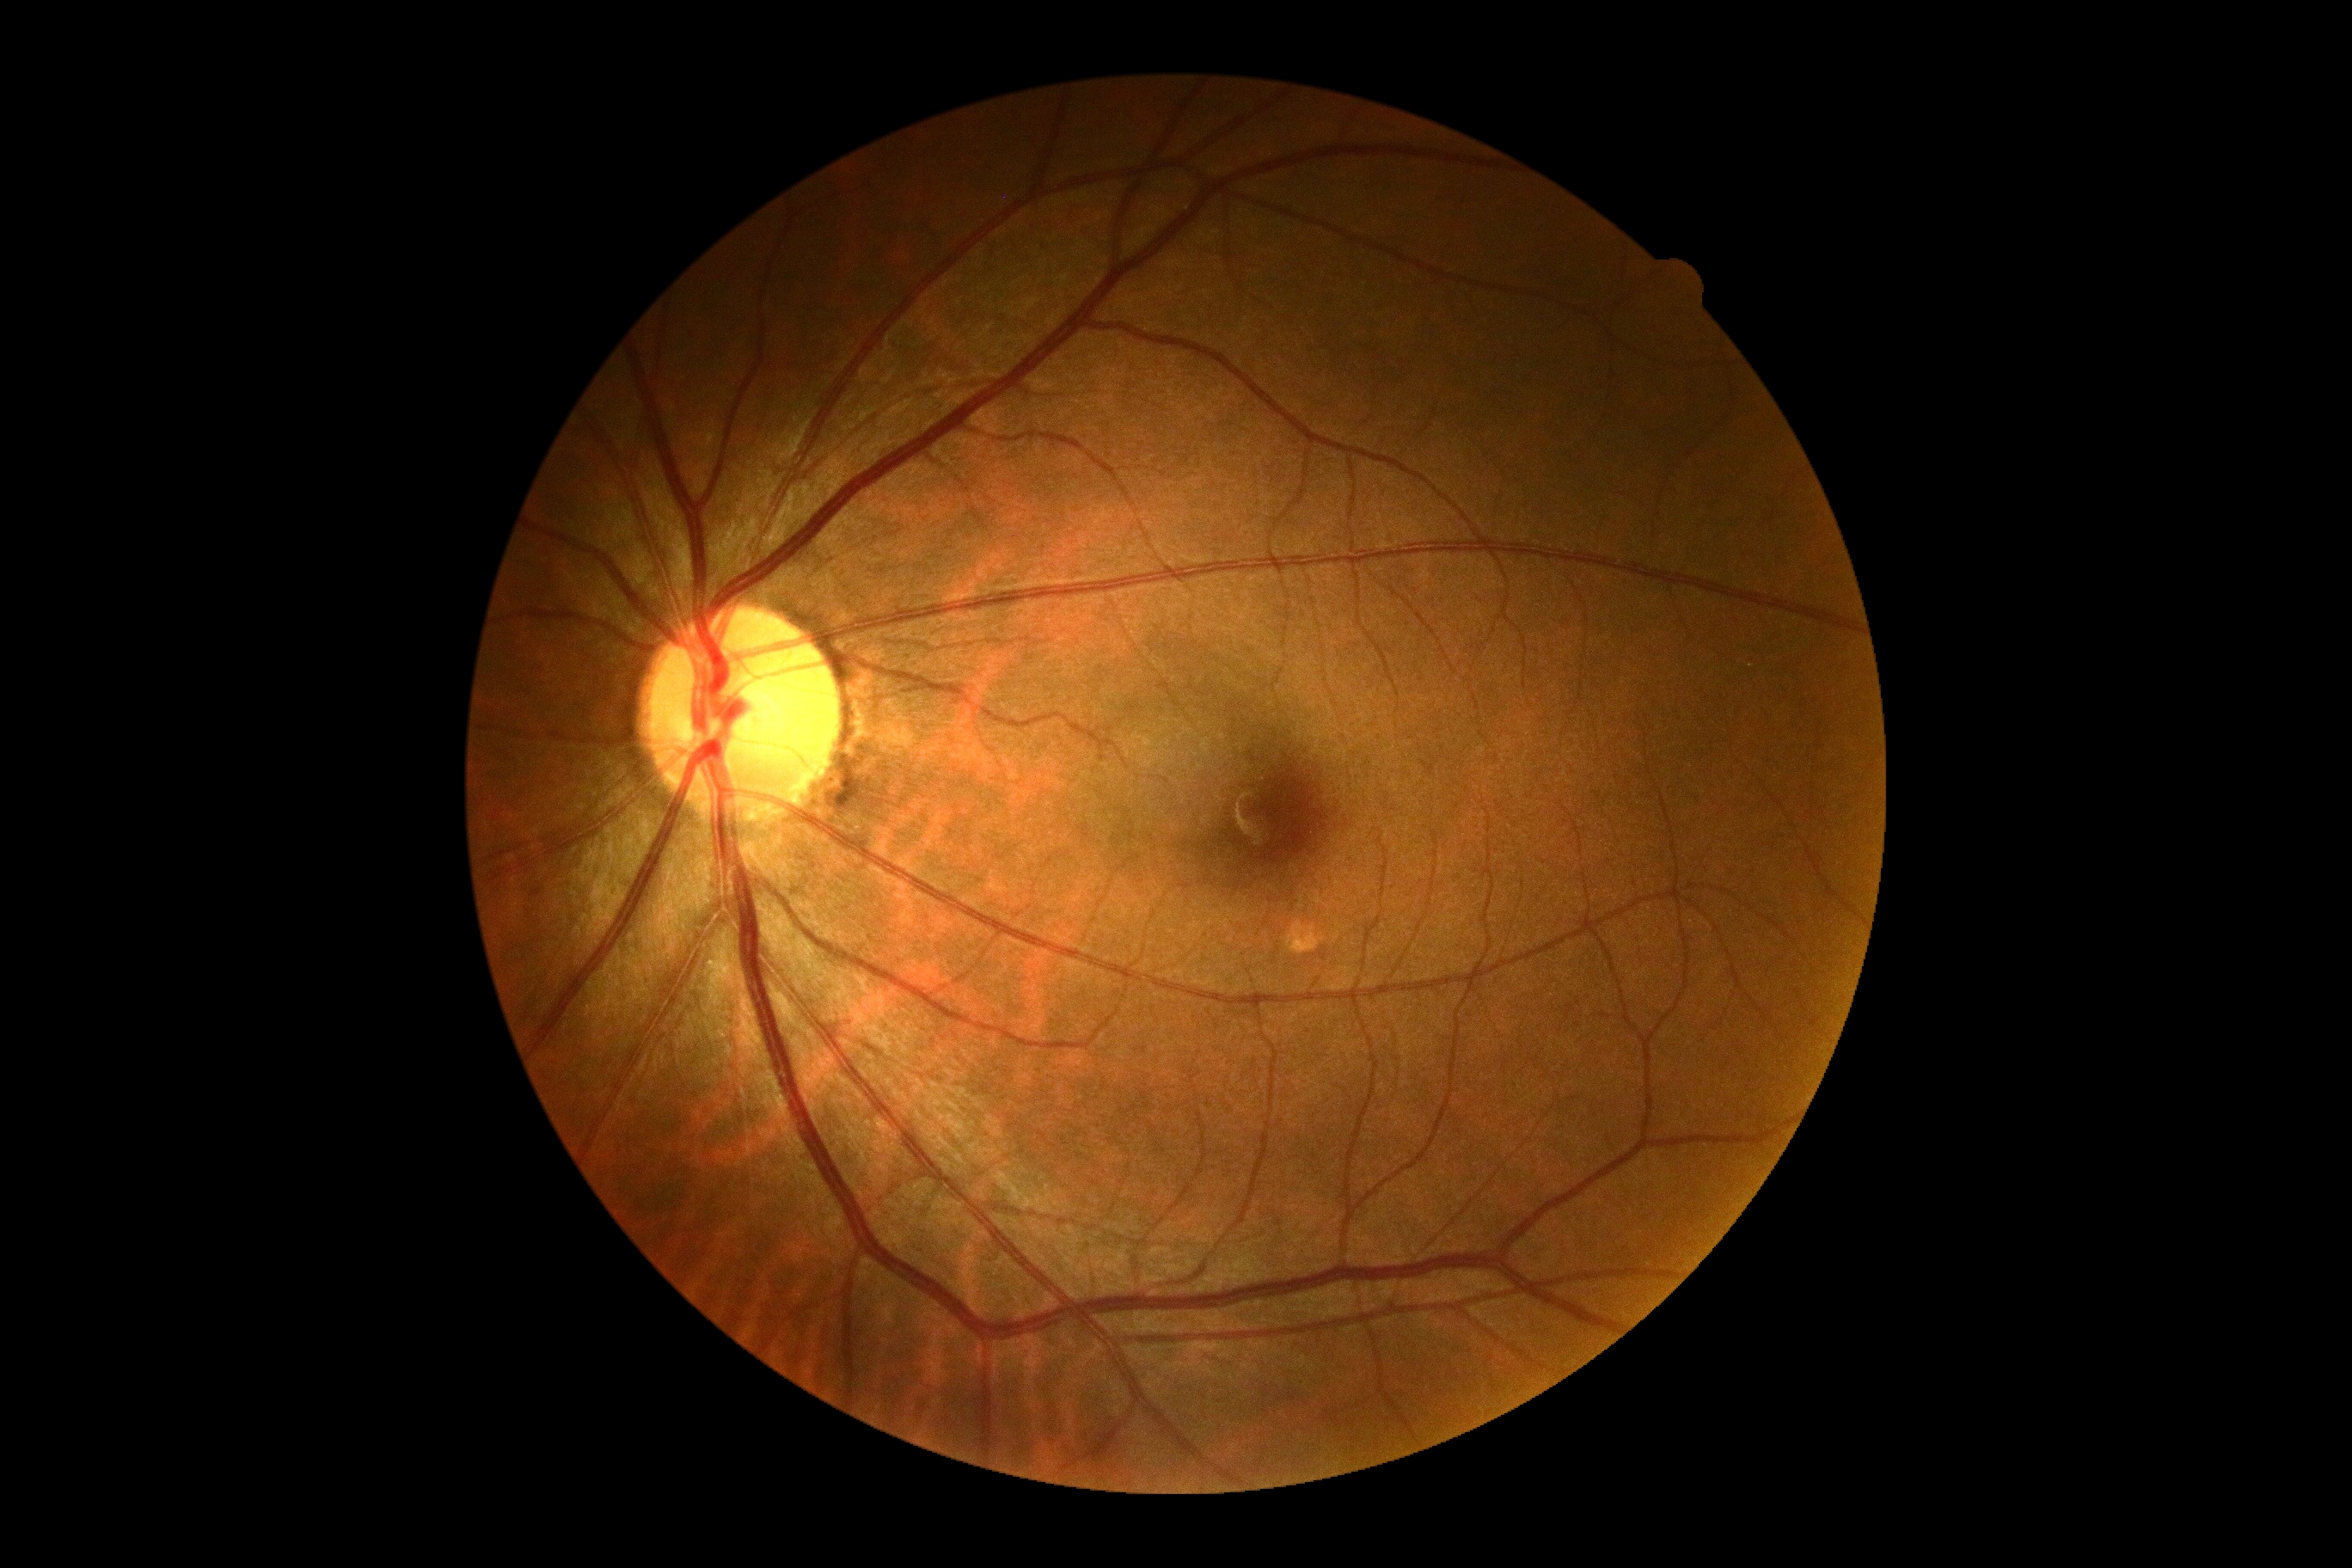 Diabetic retinopathy grade is 0.